Retinal fundus photograph; 240x240:
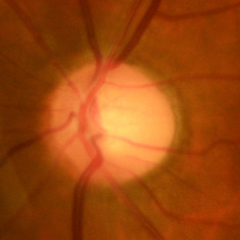

Early glaucomatous changes.